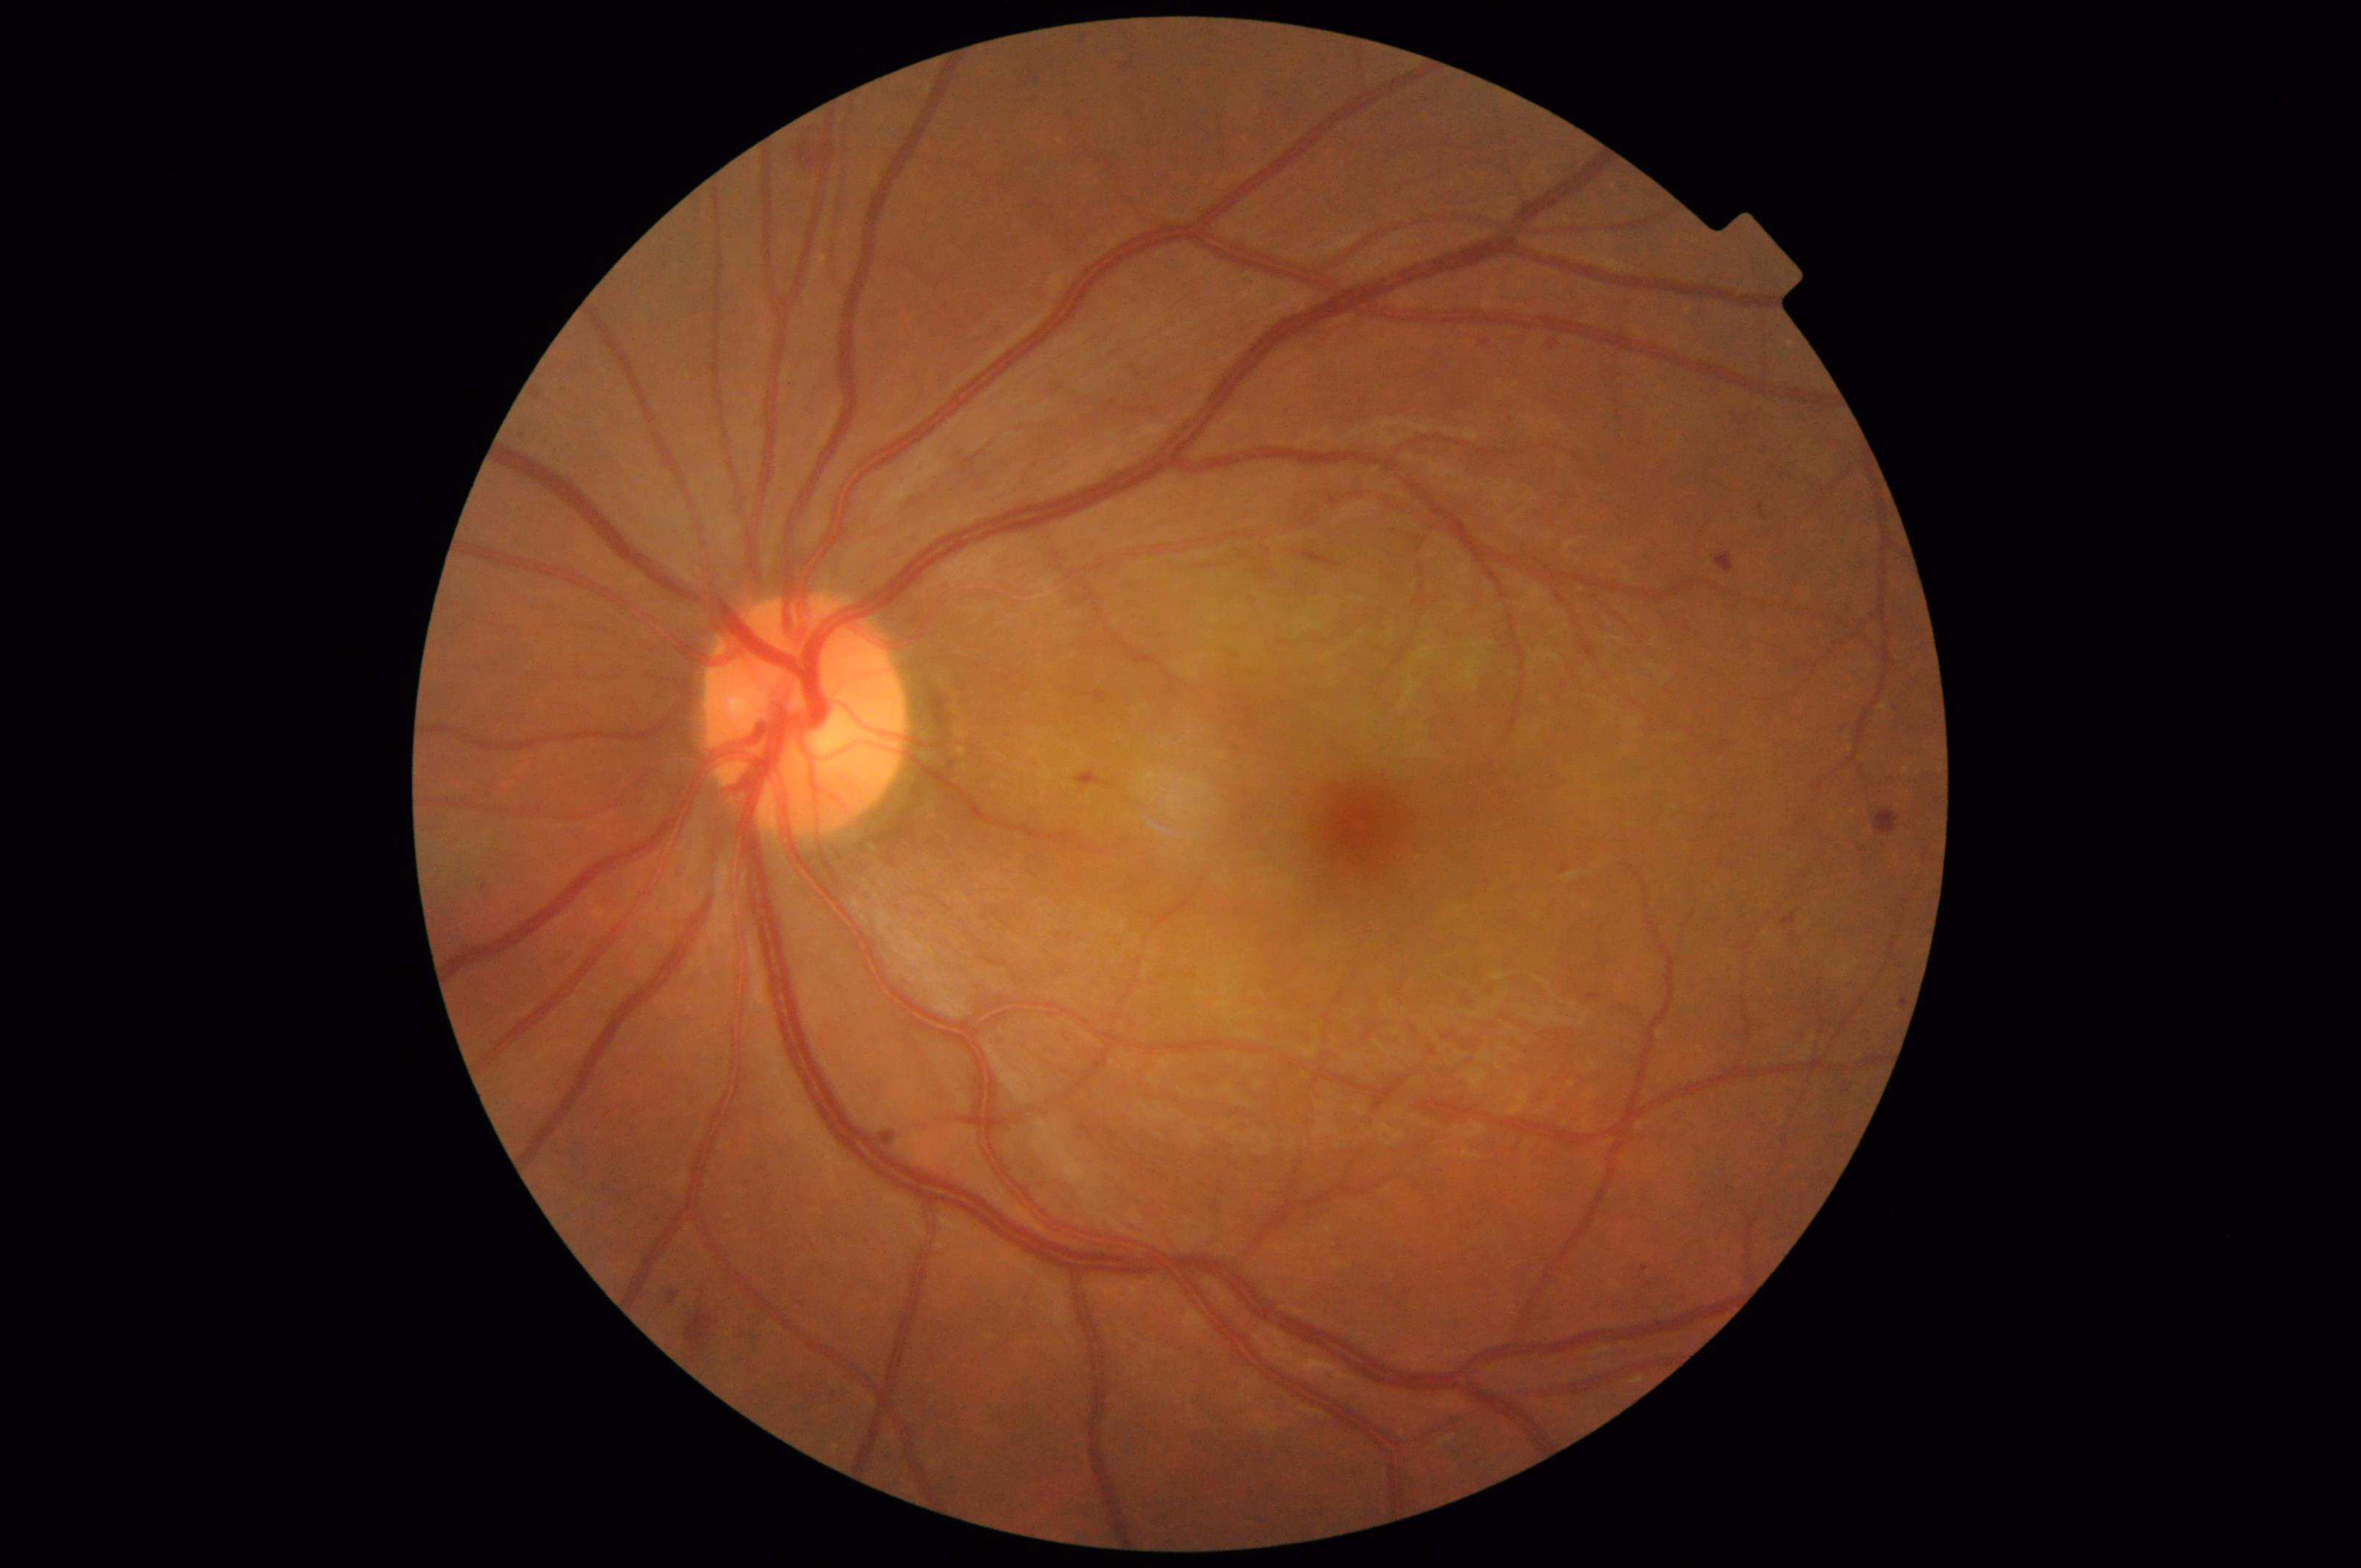

Image quality assessment:
- sharpness: clear with no noticeable blur
- overall: adequate for clinical interpretation
- contrast: good dynamic range
- illumination/color: uniform, no color cast